45° field of view.
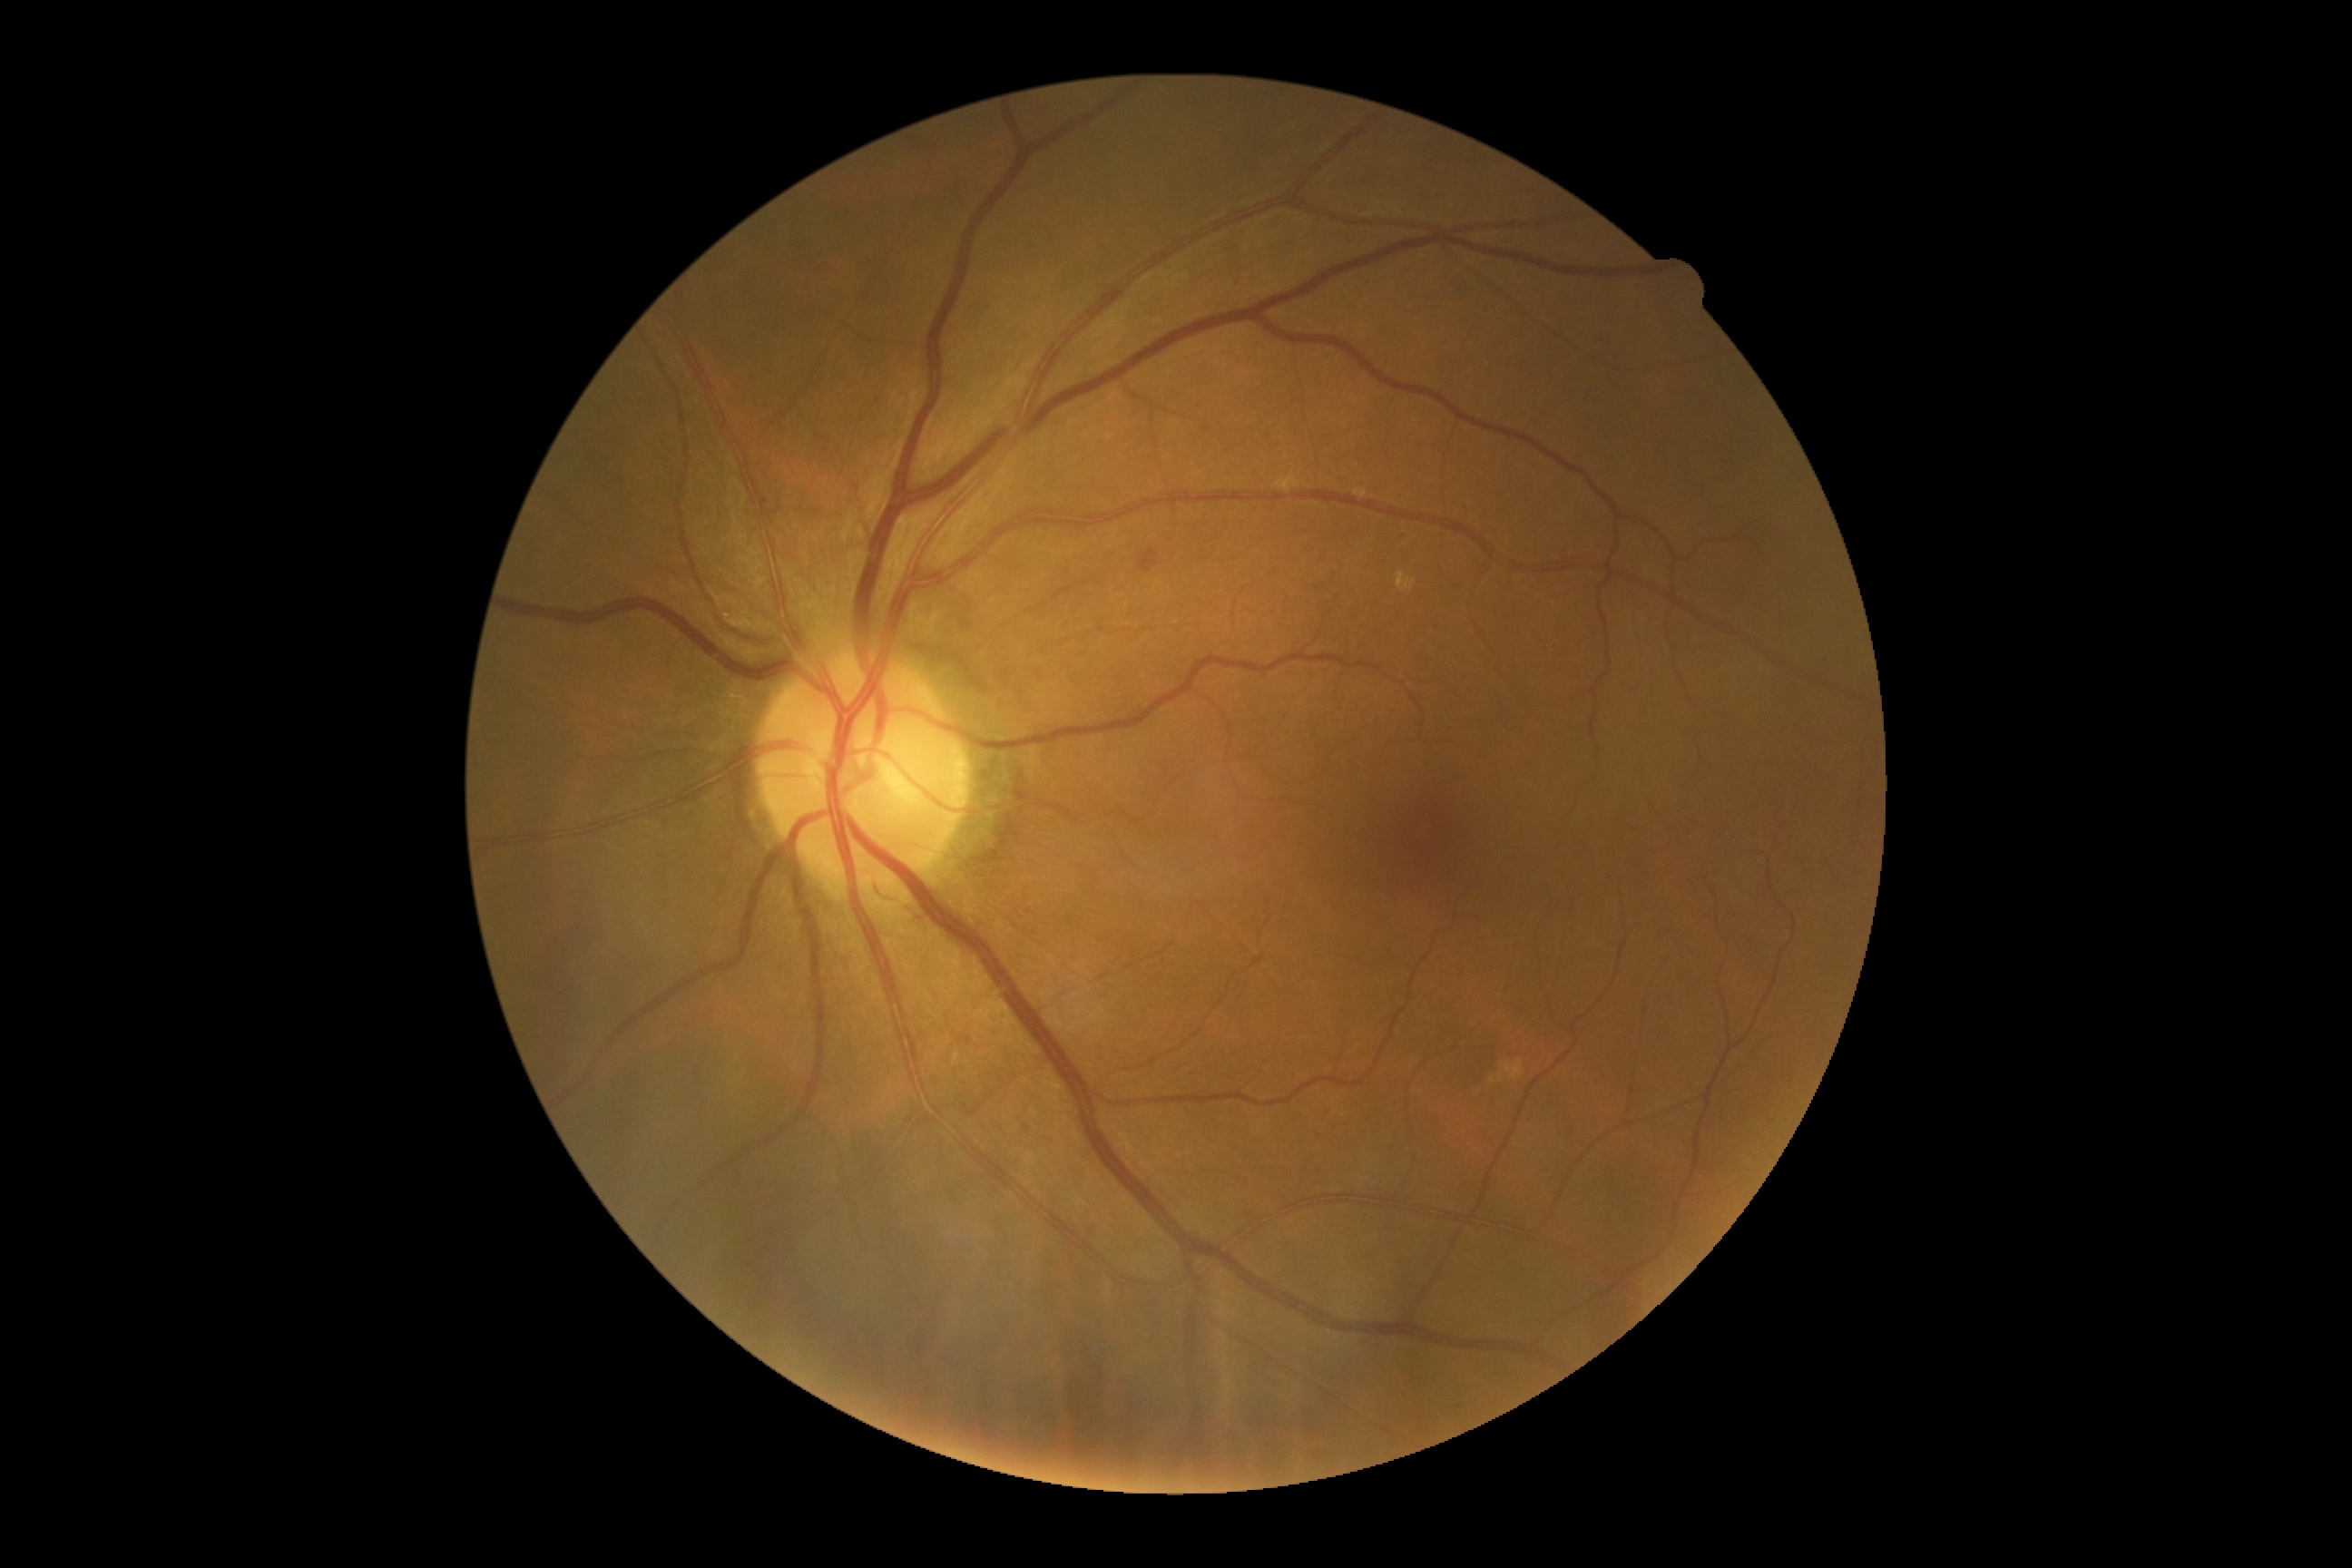 Annotations:
– diabetic retinopathy grade: 2 (moderate NPDR)